Color fundus image — 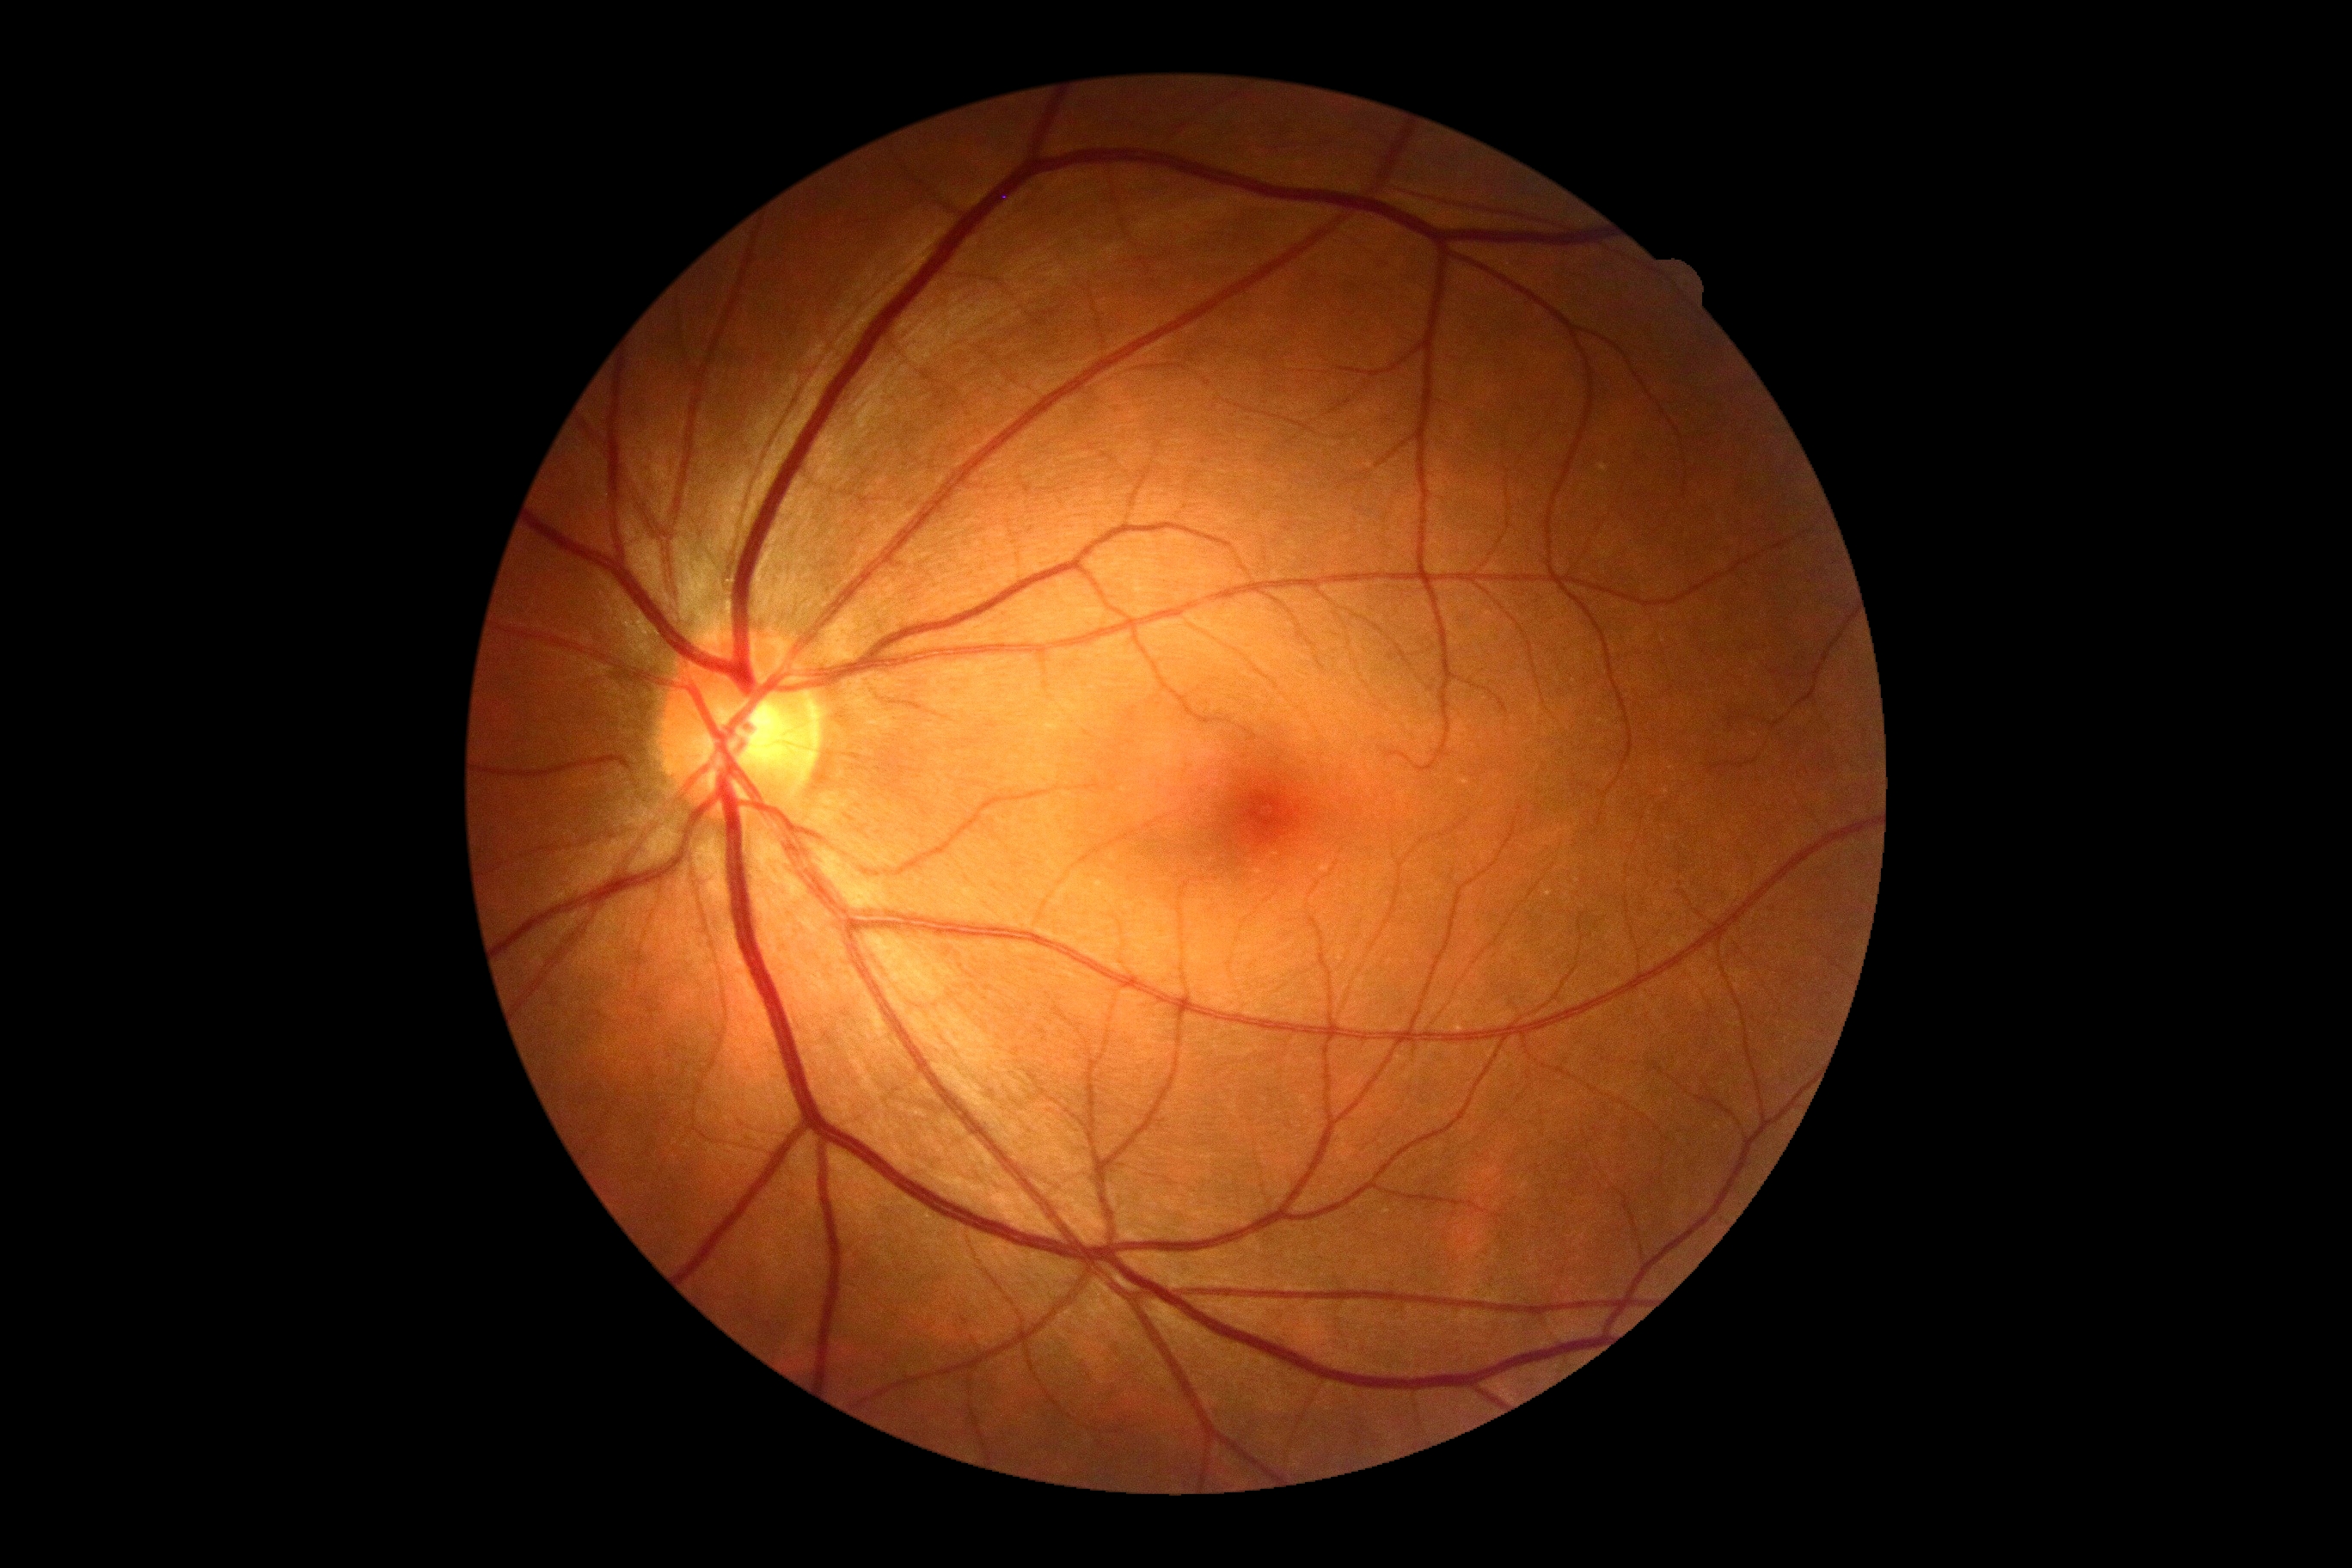
DR grade: 0 — no visible signs of diabetic retinopathy.